Infant wide-field retinal image; 1440x1080:
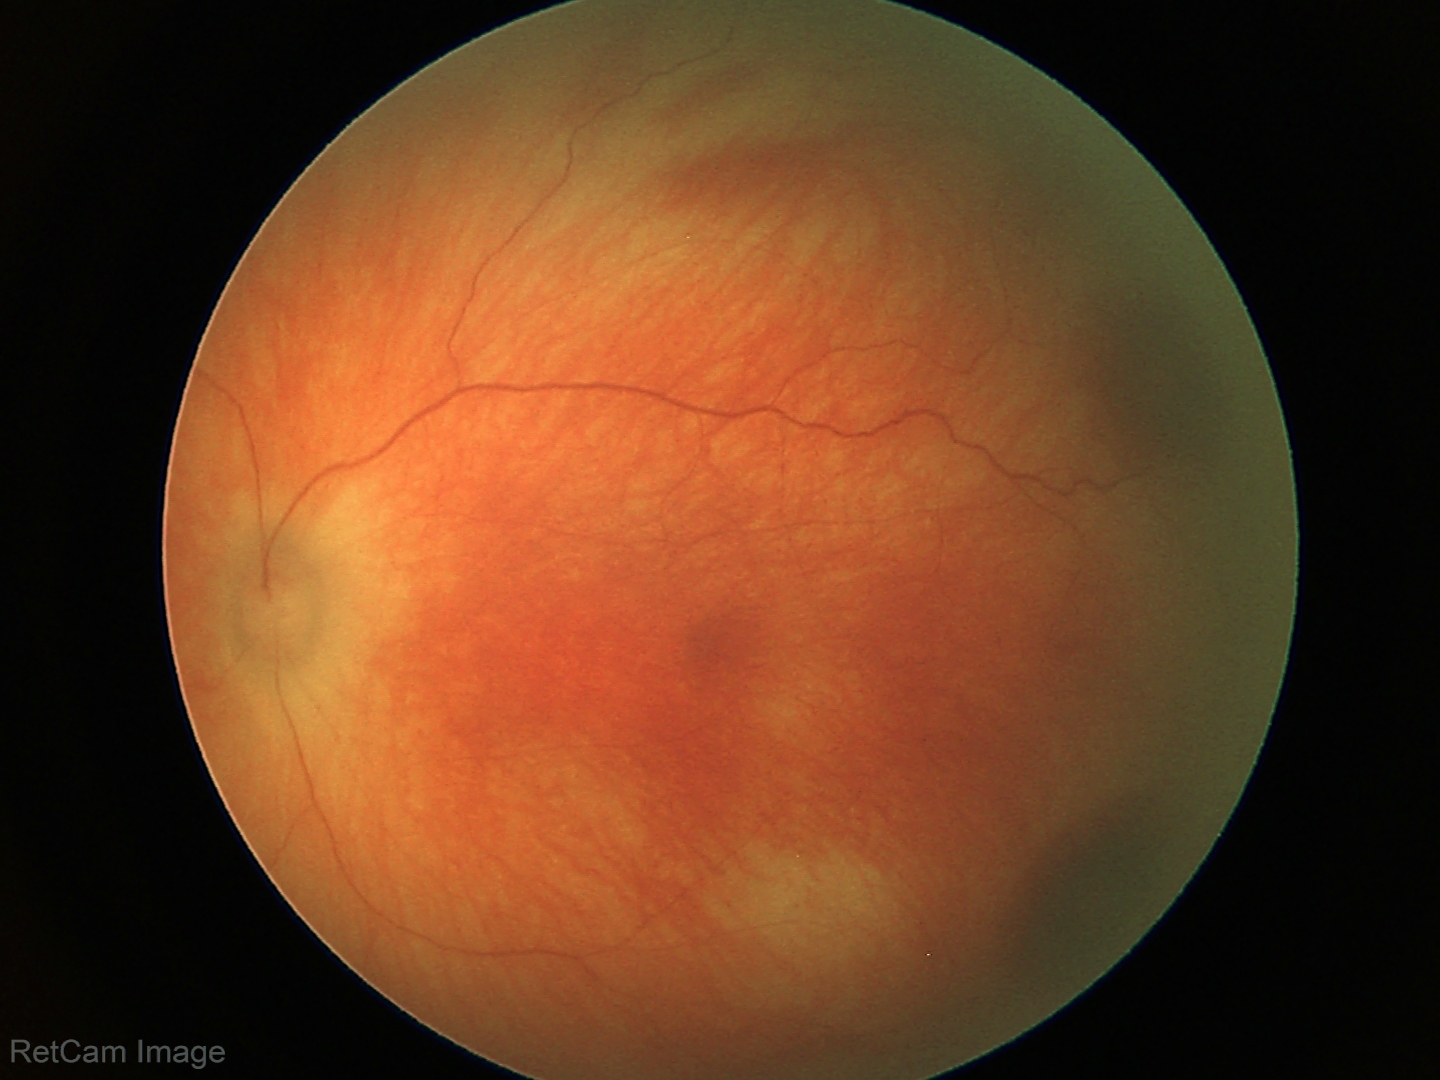

Diagnosis from this screening exam: retinal hemorrhages.